2352x1568.
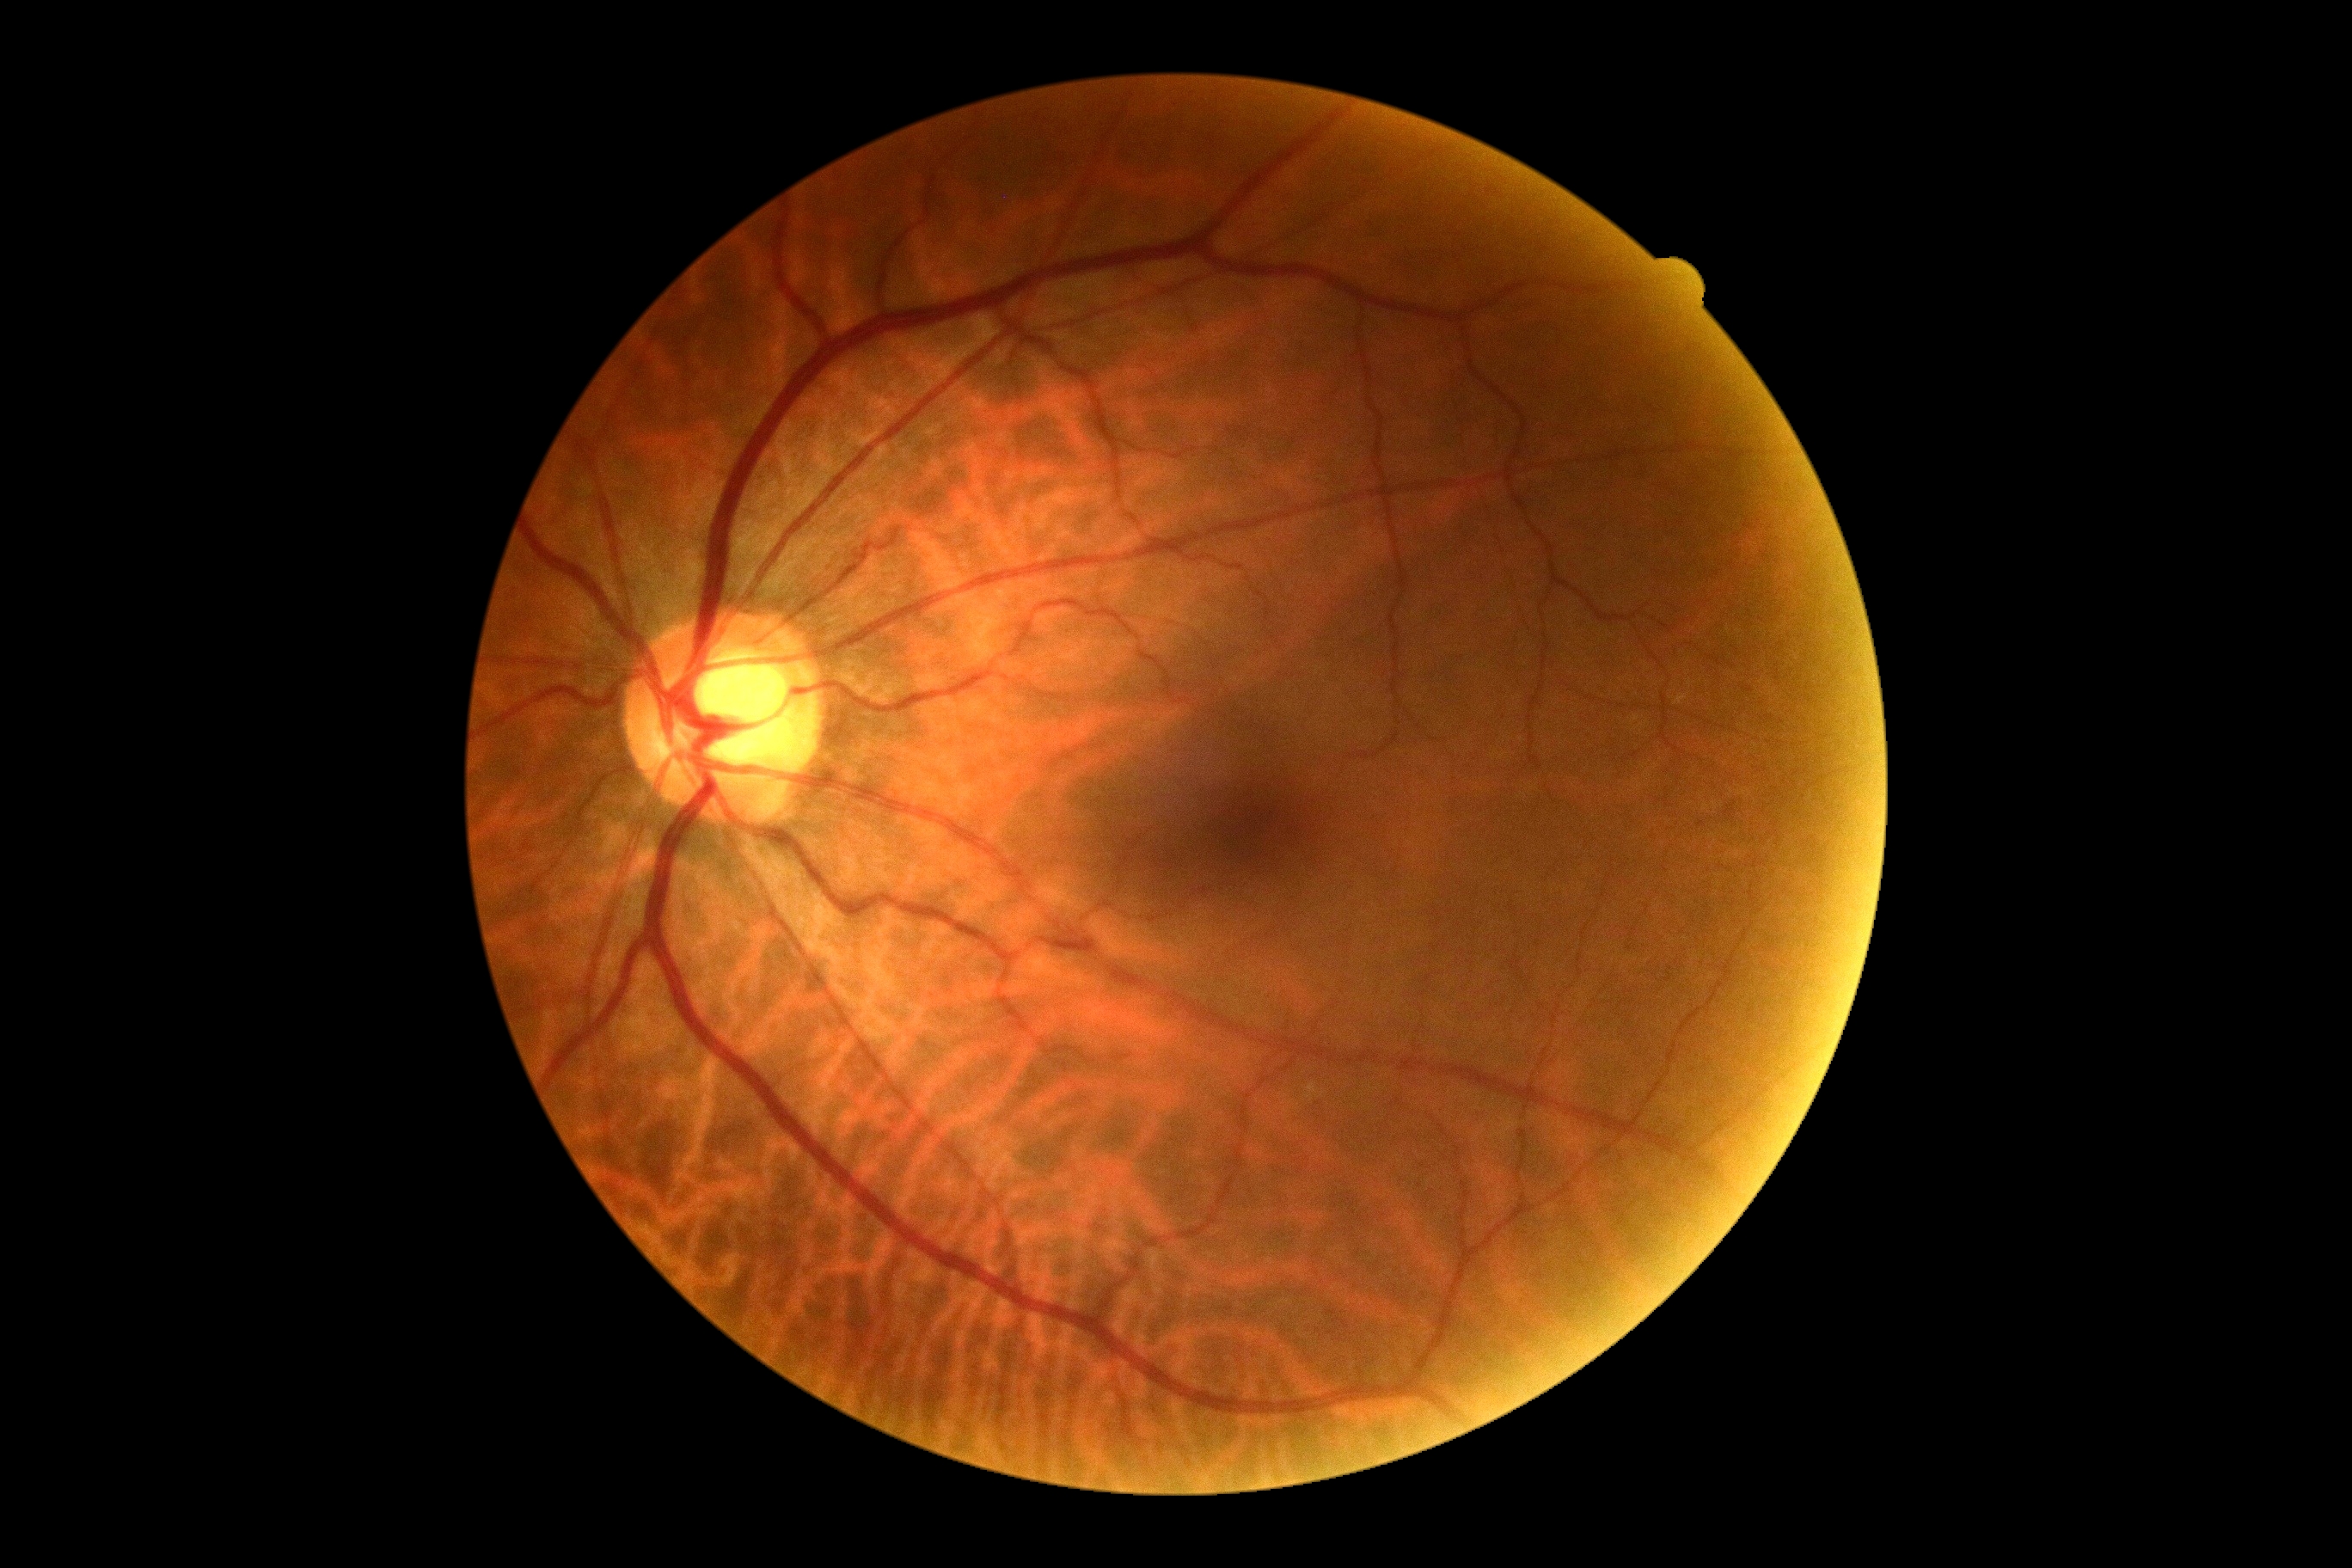 Diabetic retinopathy grade is 0.